Modified Davis grading.
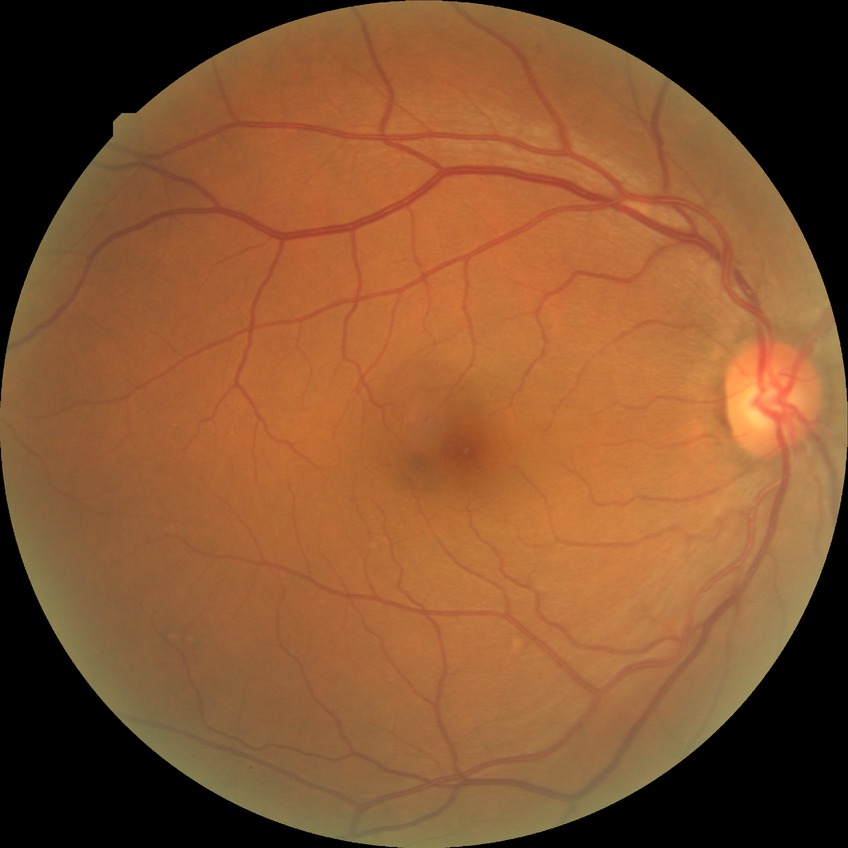 DR stage is NDR. No DR findings.